640 x 480 pixels · acquired on the Clarity RetCam 3 · wide-field fundus photograph from neonatal ROP screening
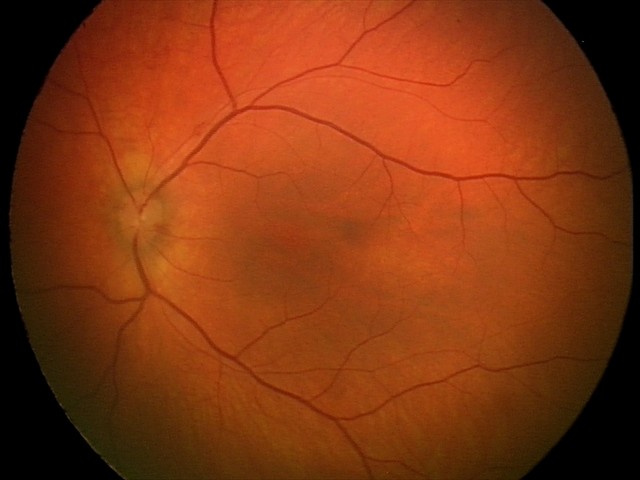

Assessment: retinal hemorrhages.